RetCam wide-field infant fundus image:
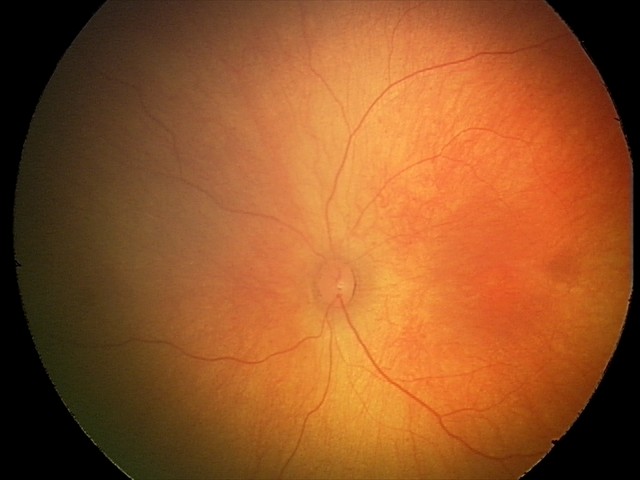 Examination with physiological retinal findings.